FOV: 45 degrees; color fundus image
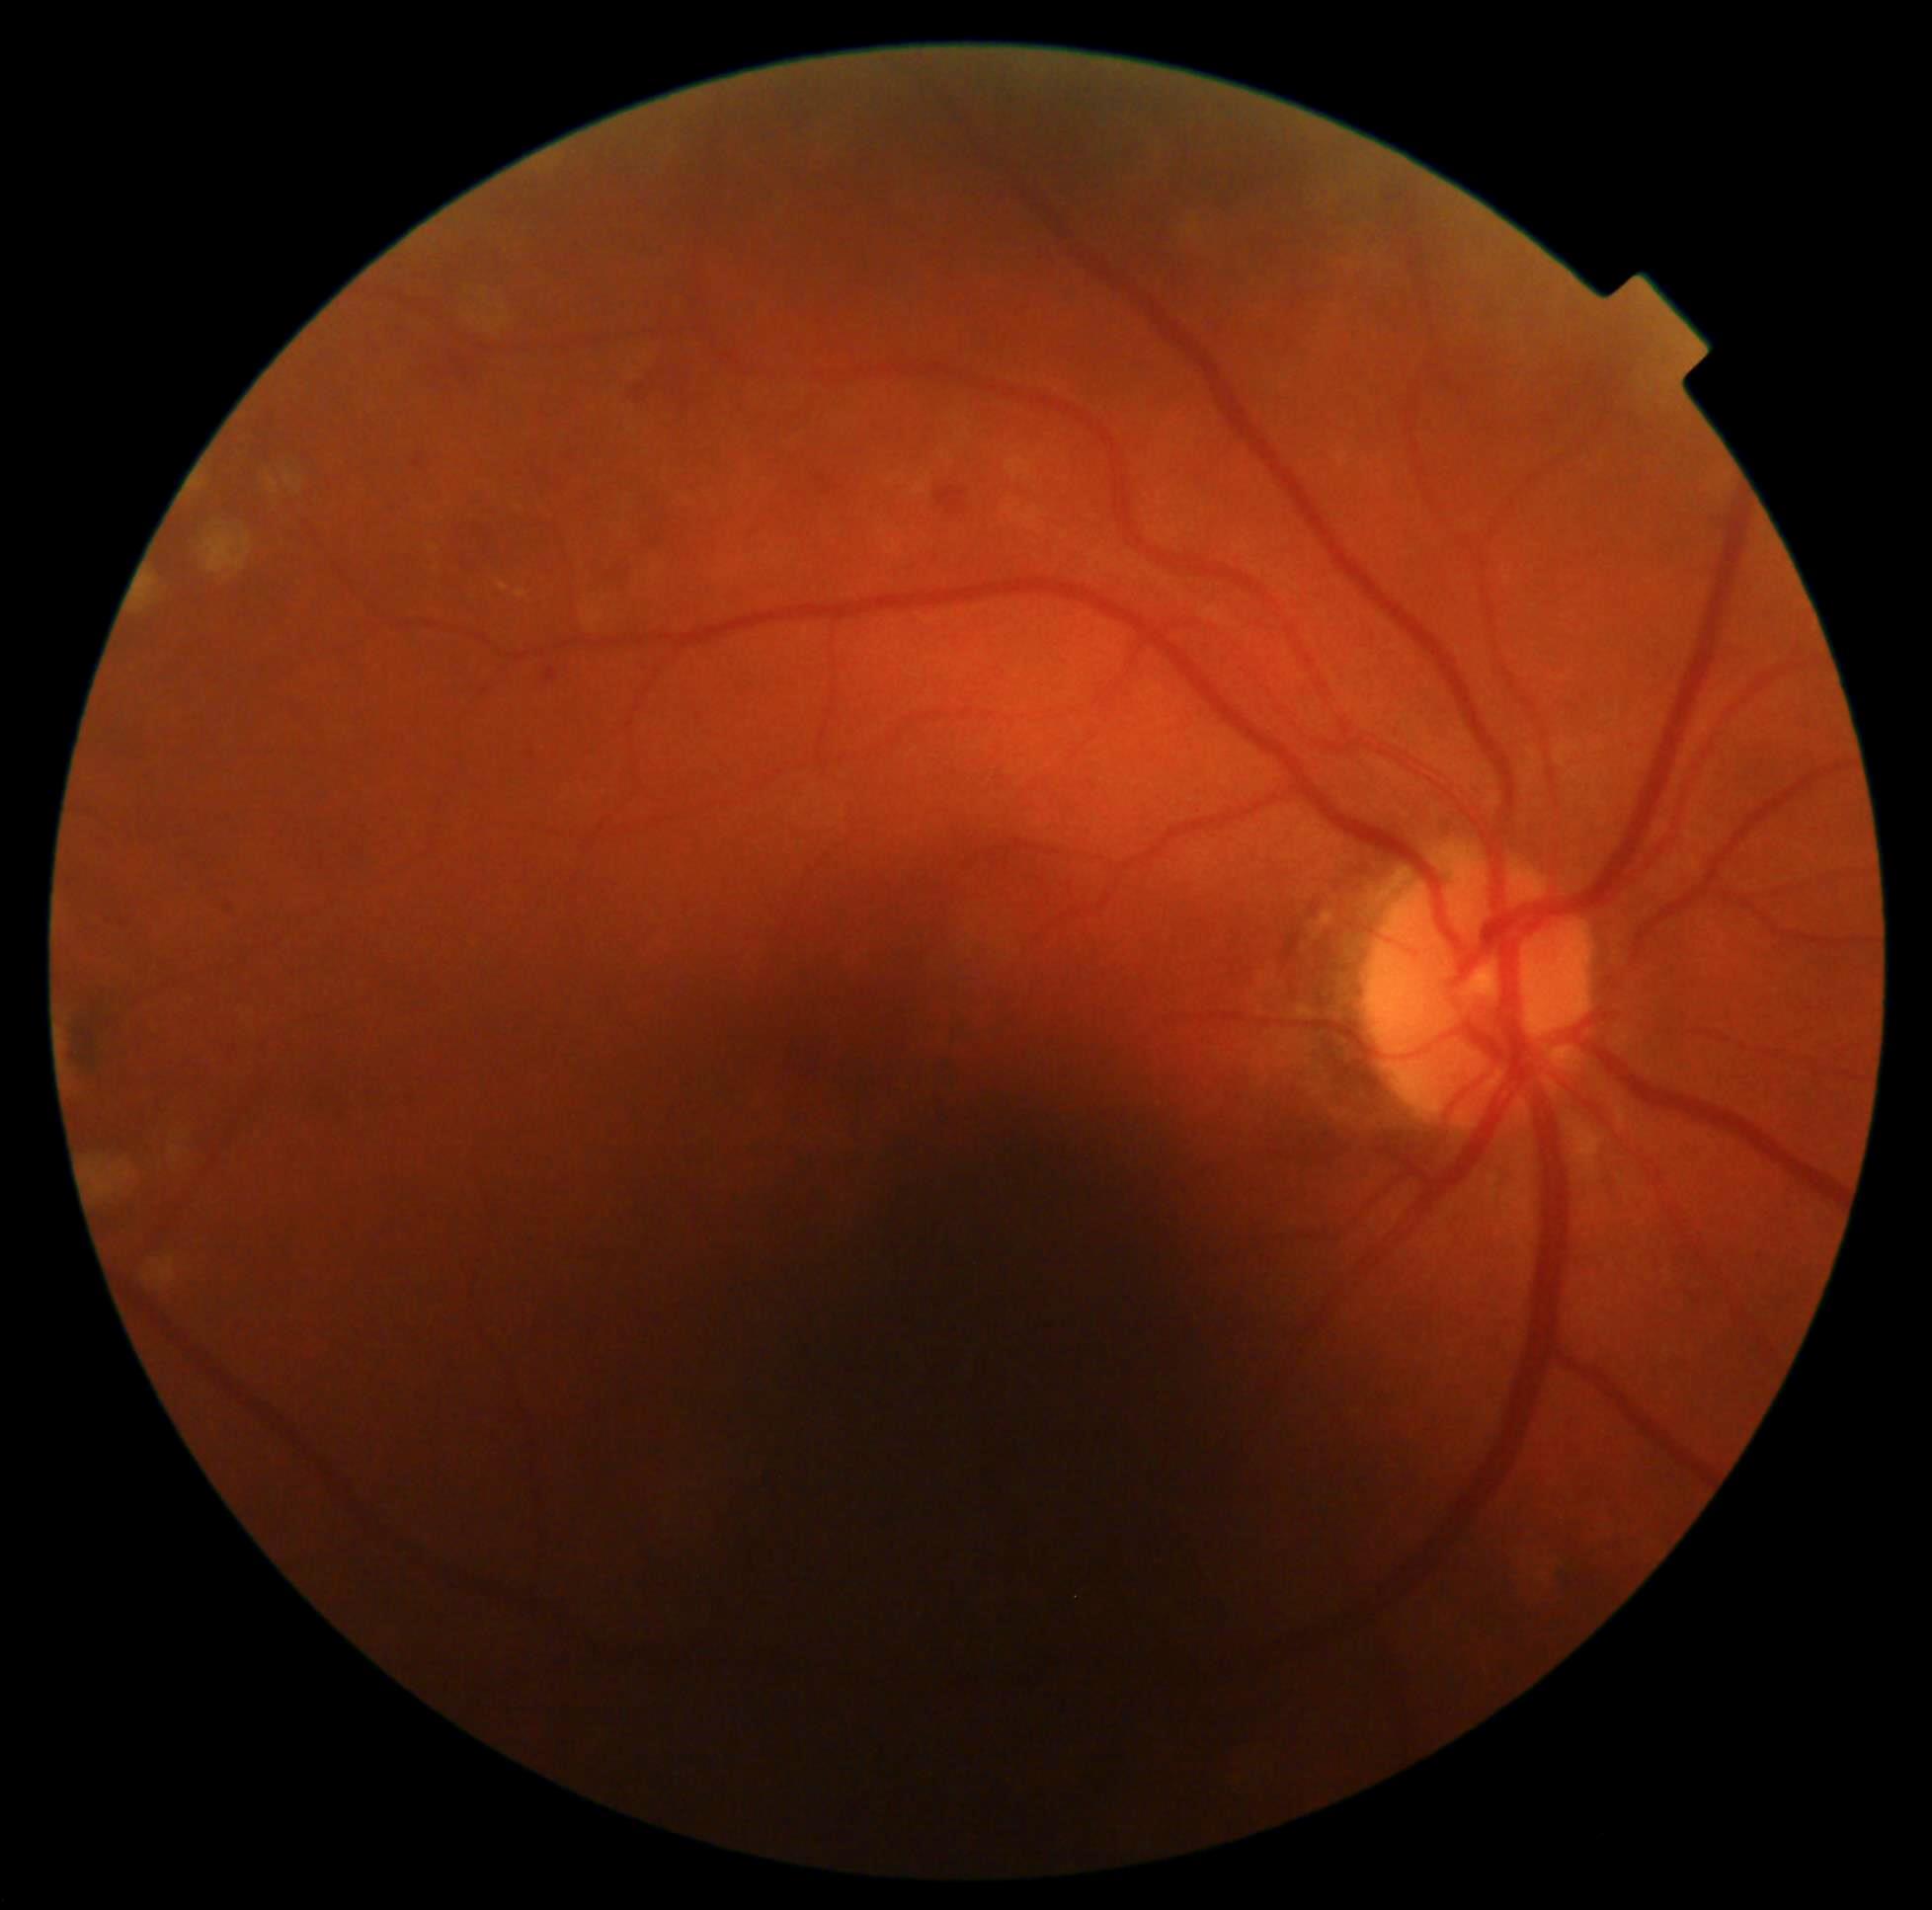   dr_grade: 2